45° field of view.
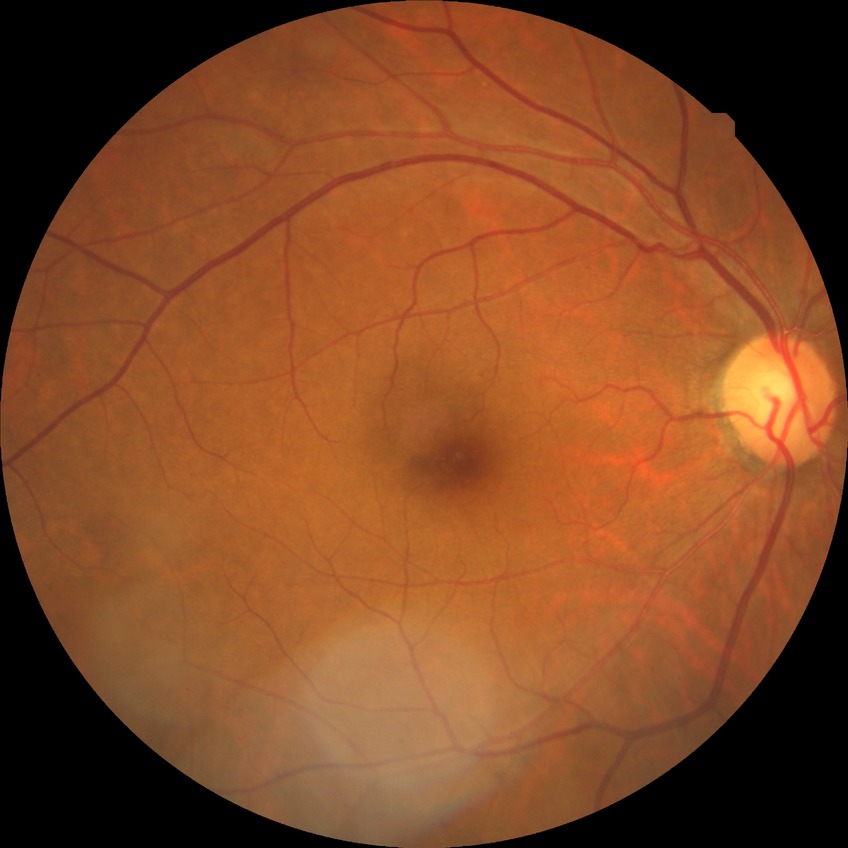
Davis DR grade is SDR.